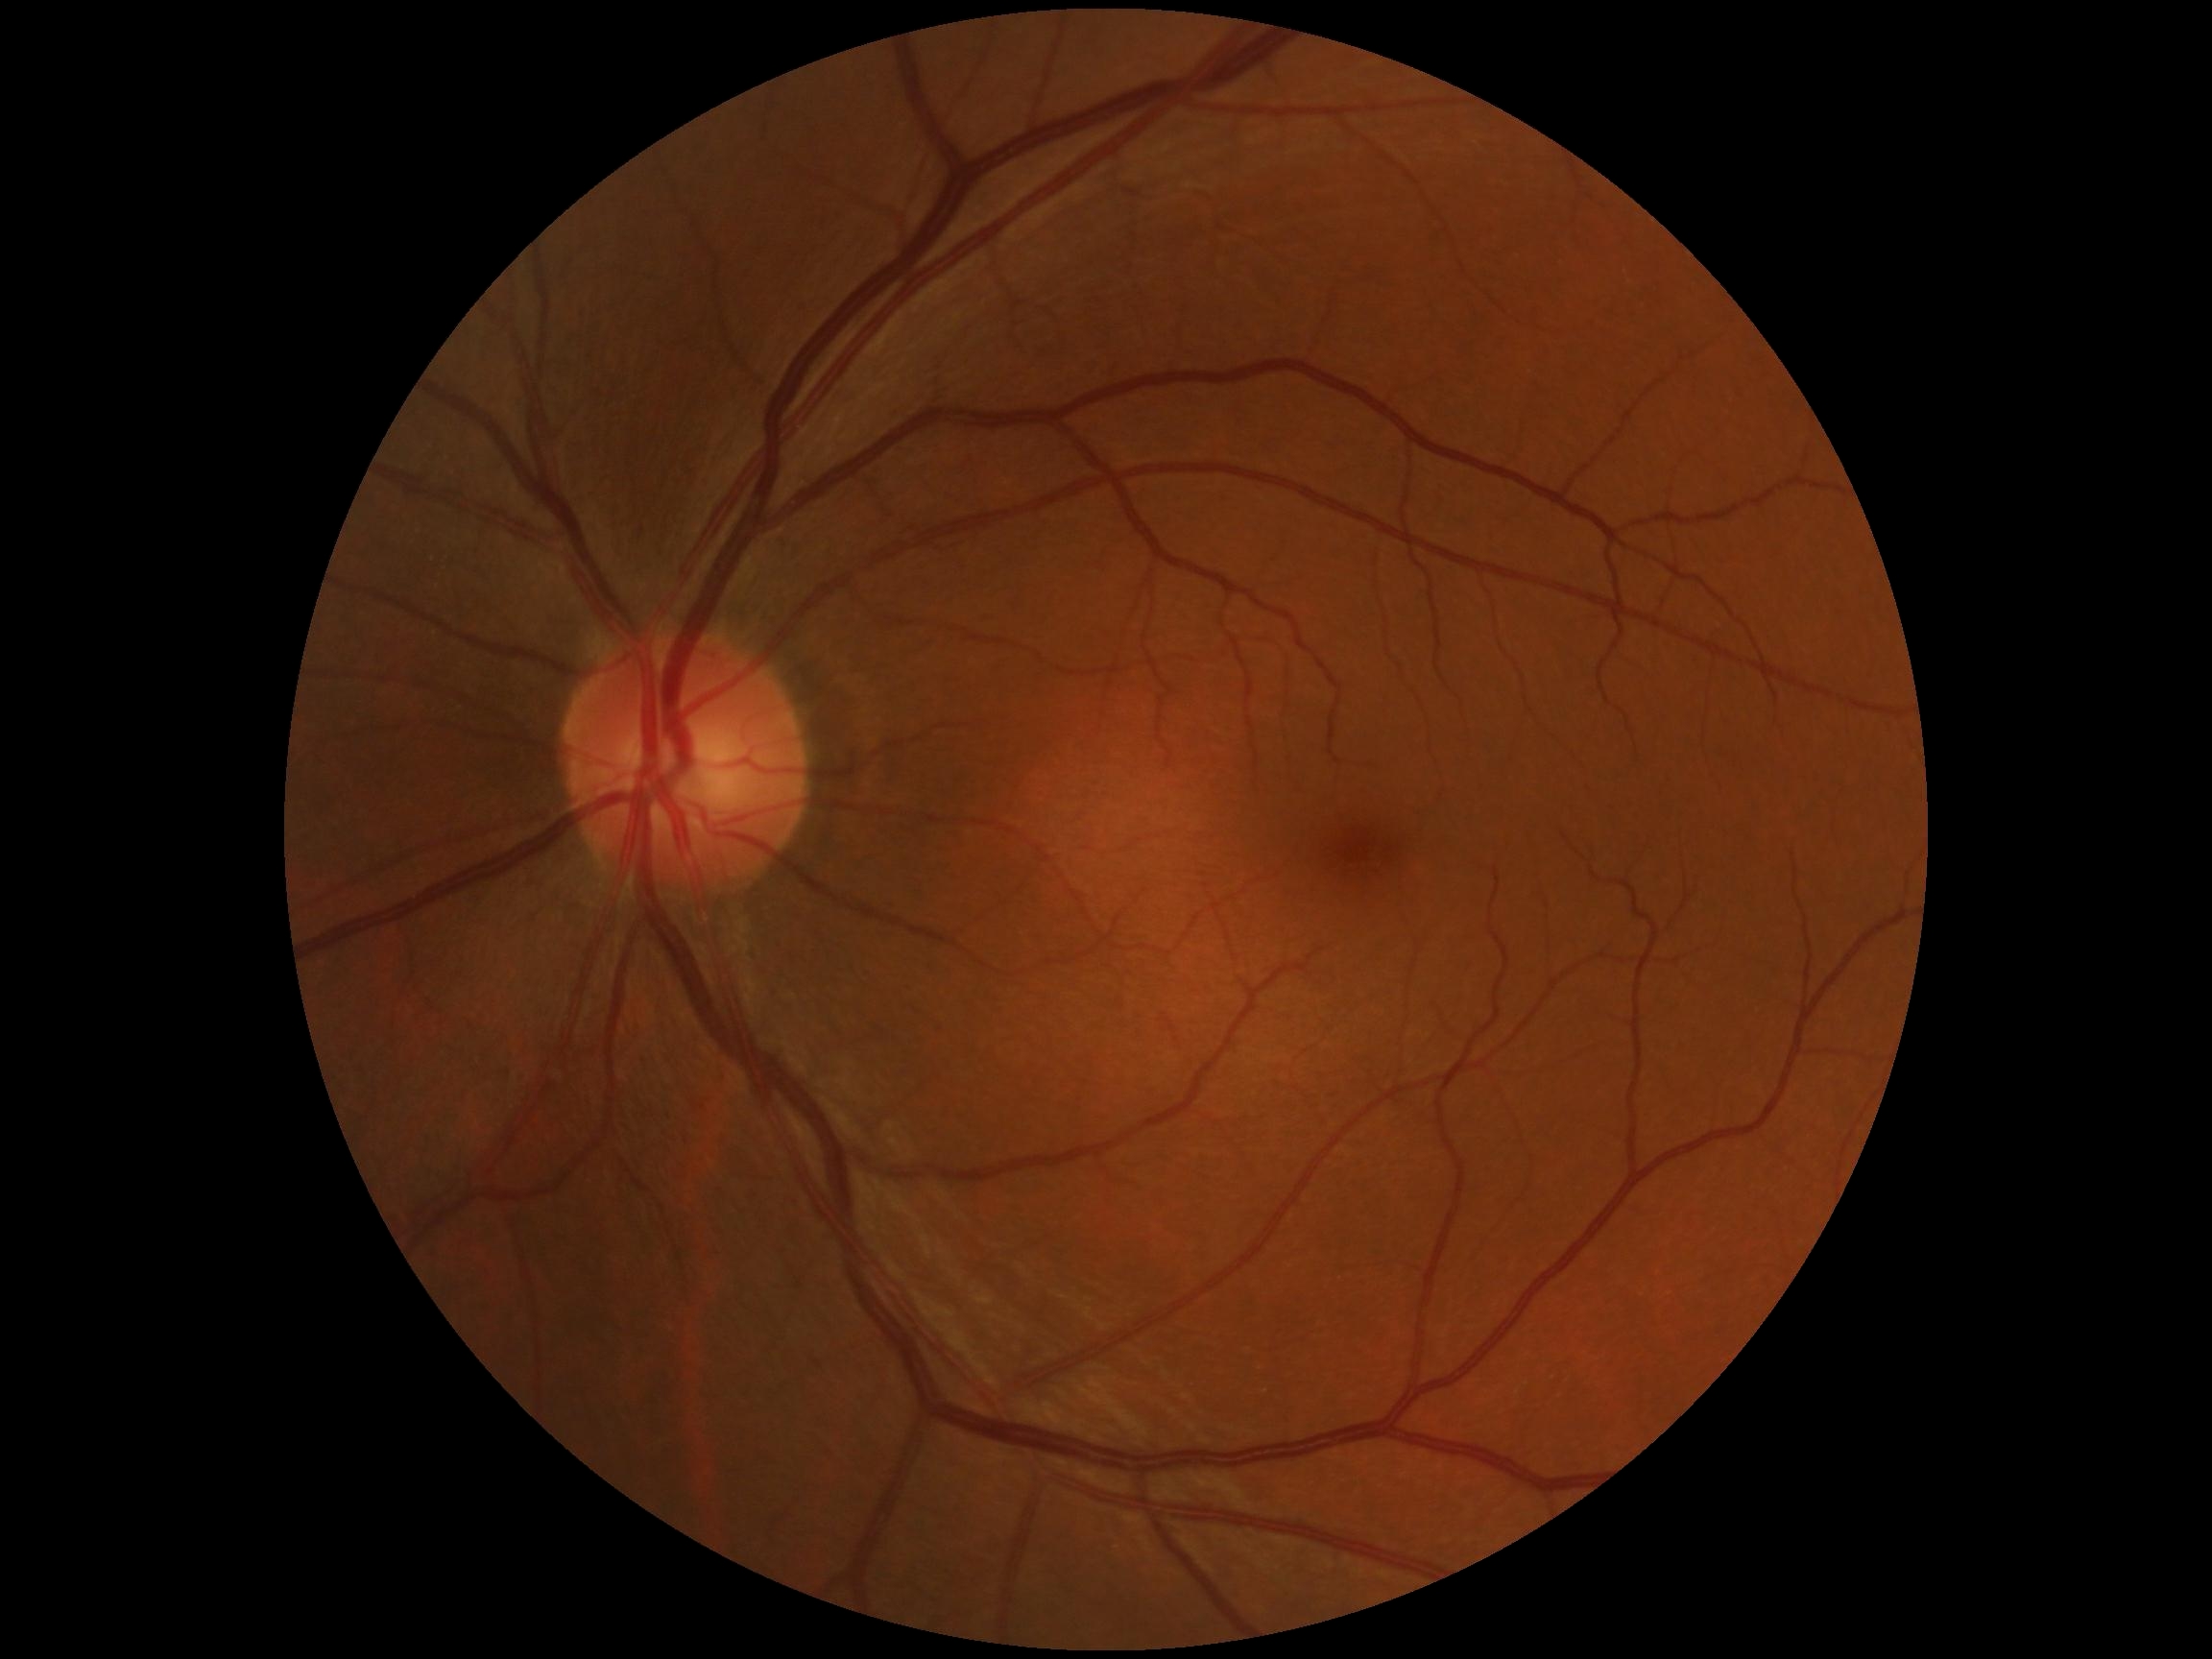 DR grade is 0.